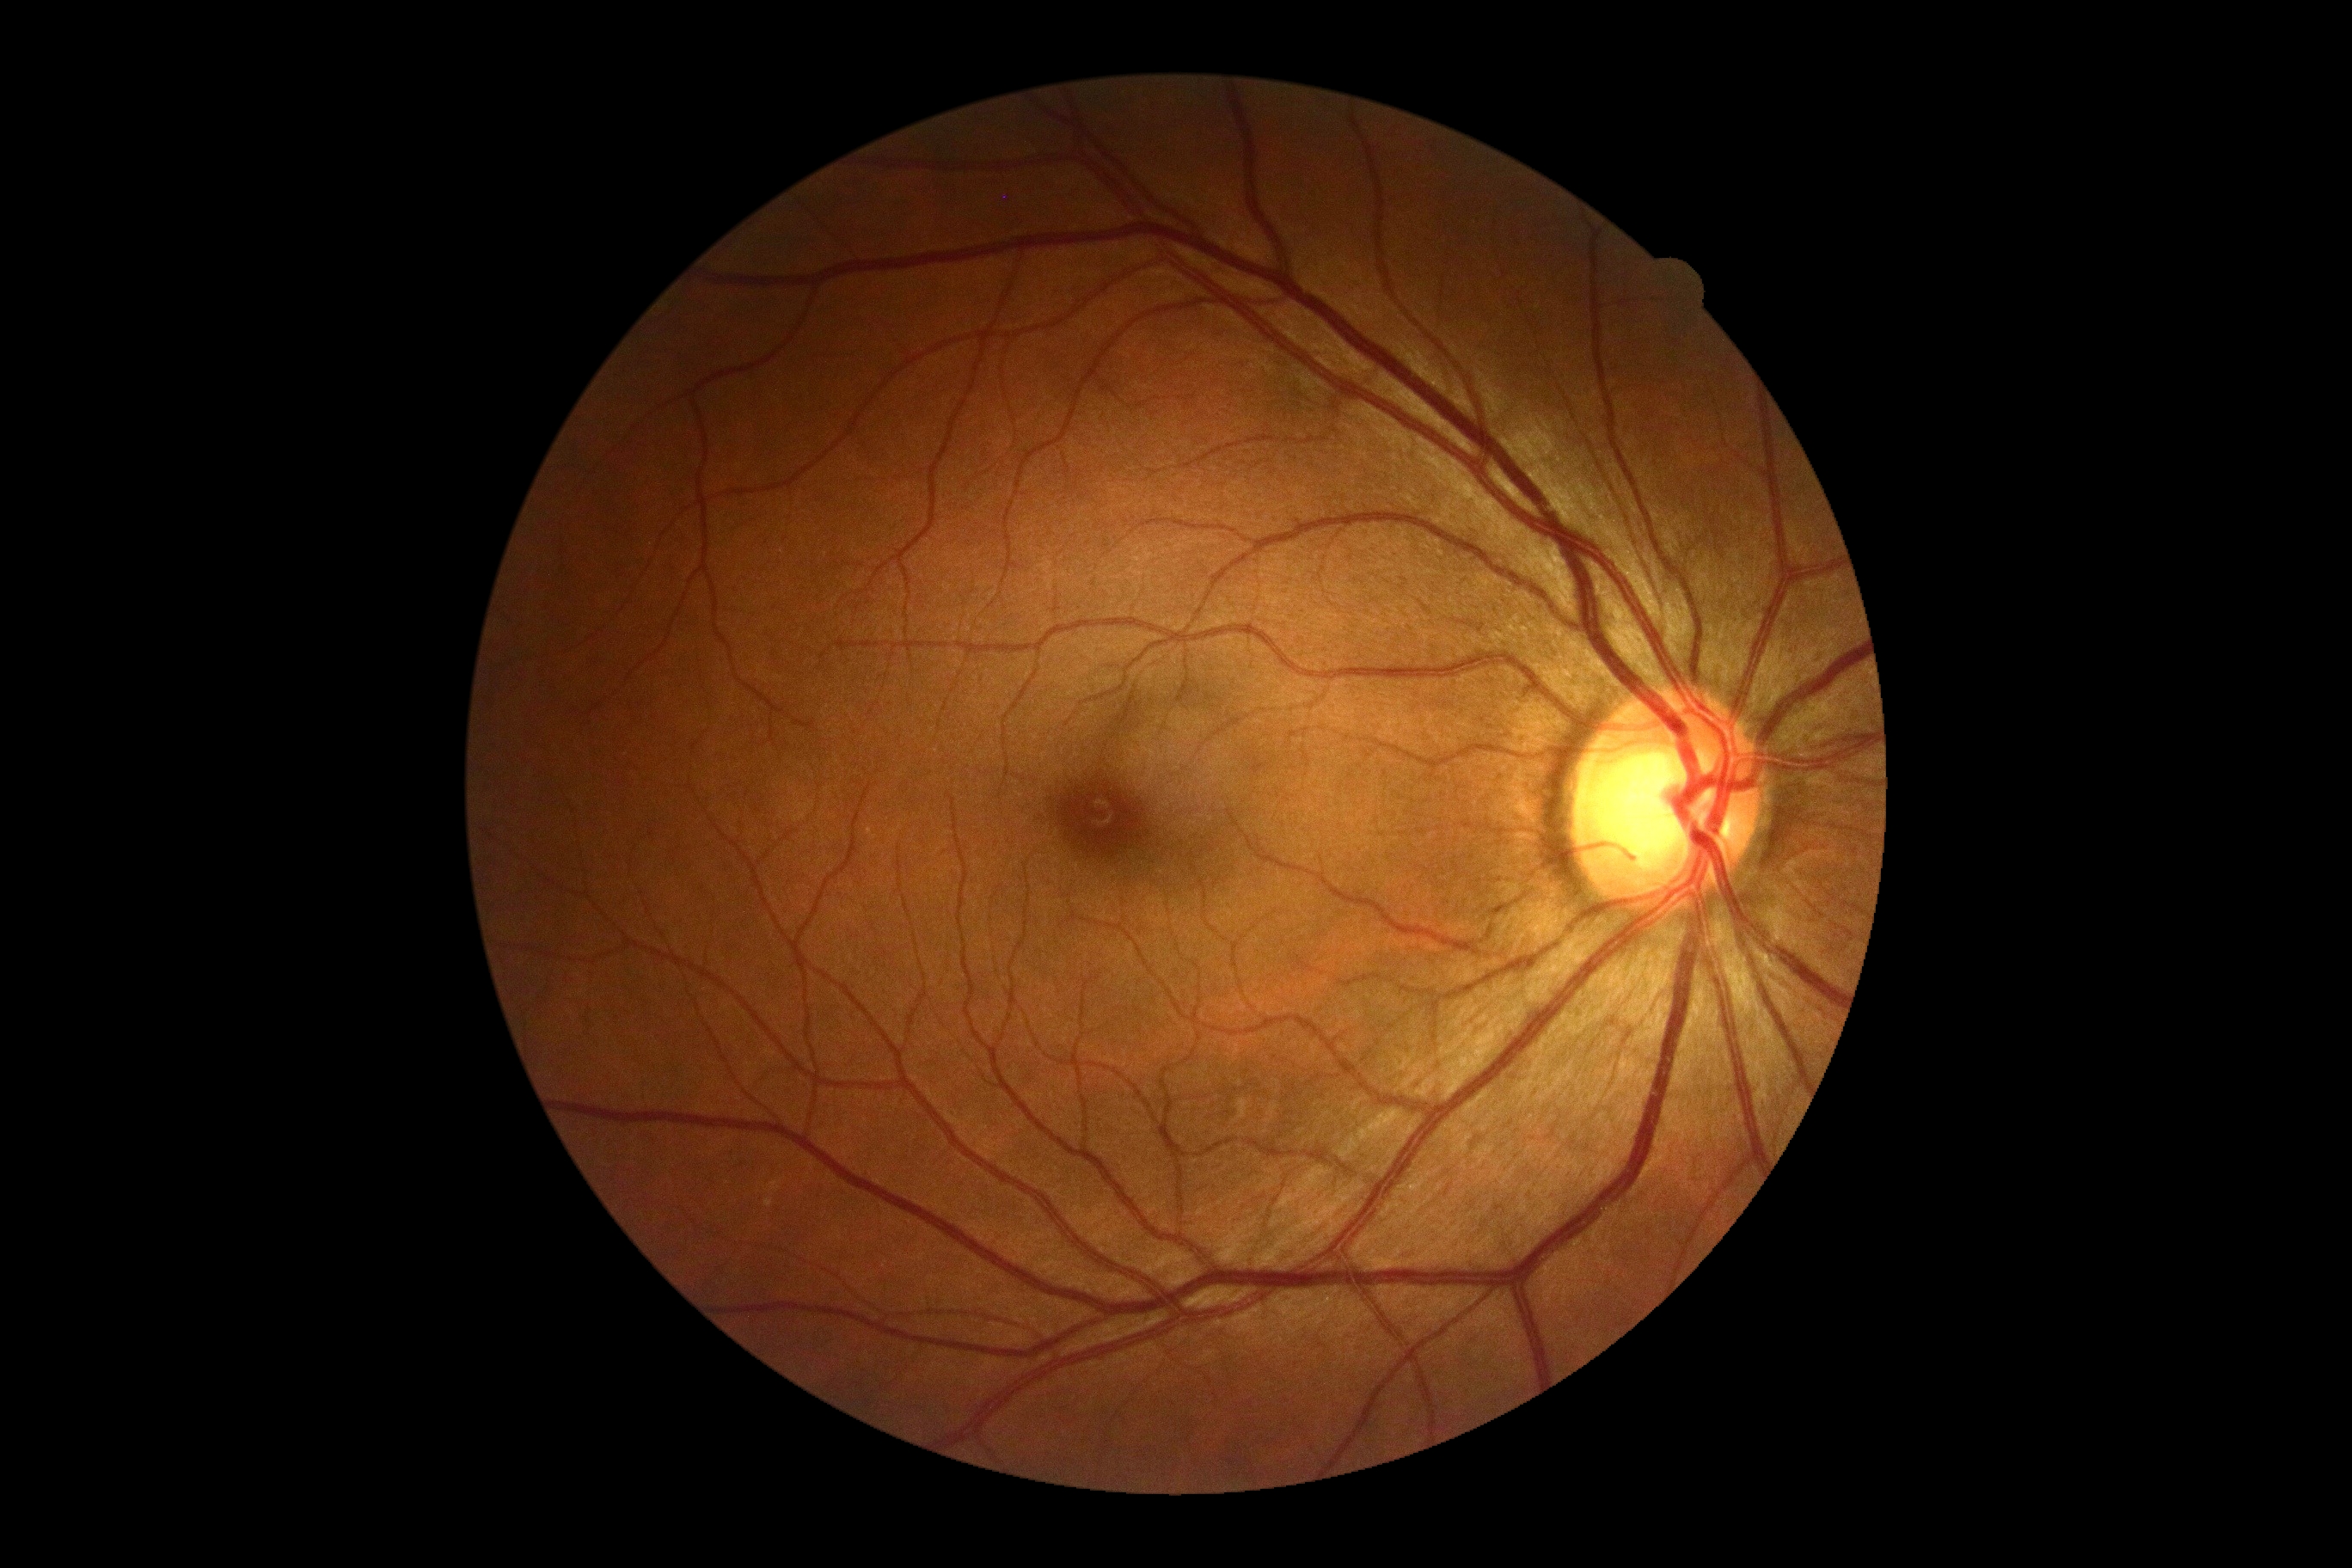
Diabetic retinopathy (DR): no apparent retinopathy (grade 0).